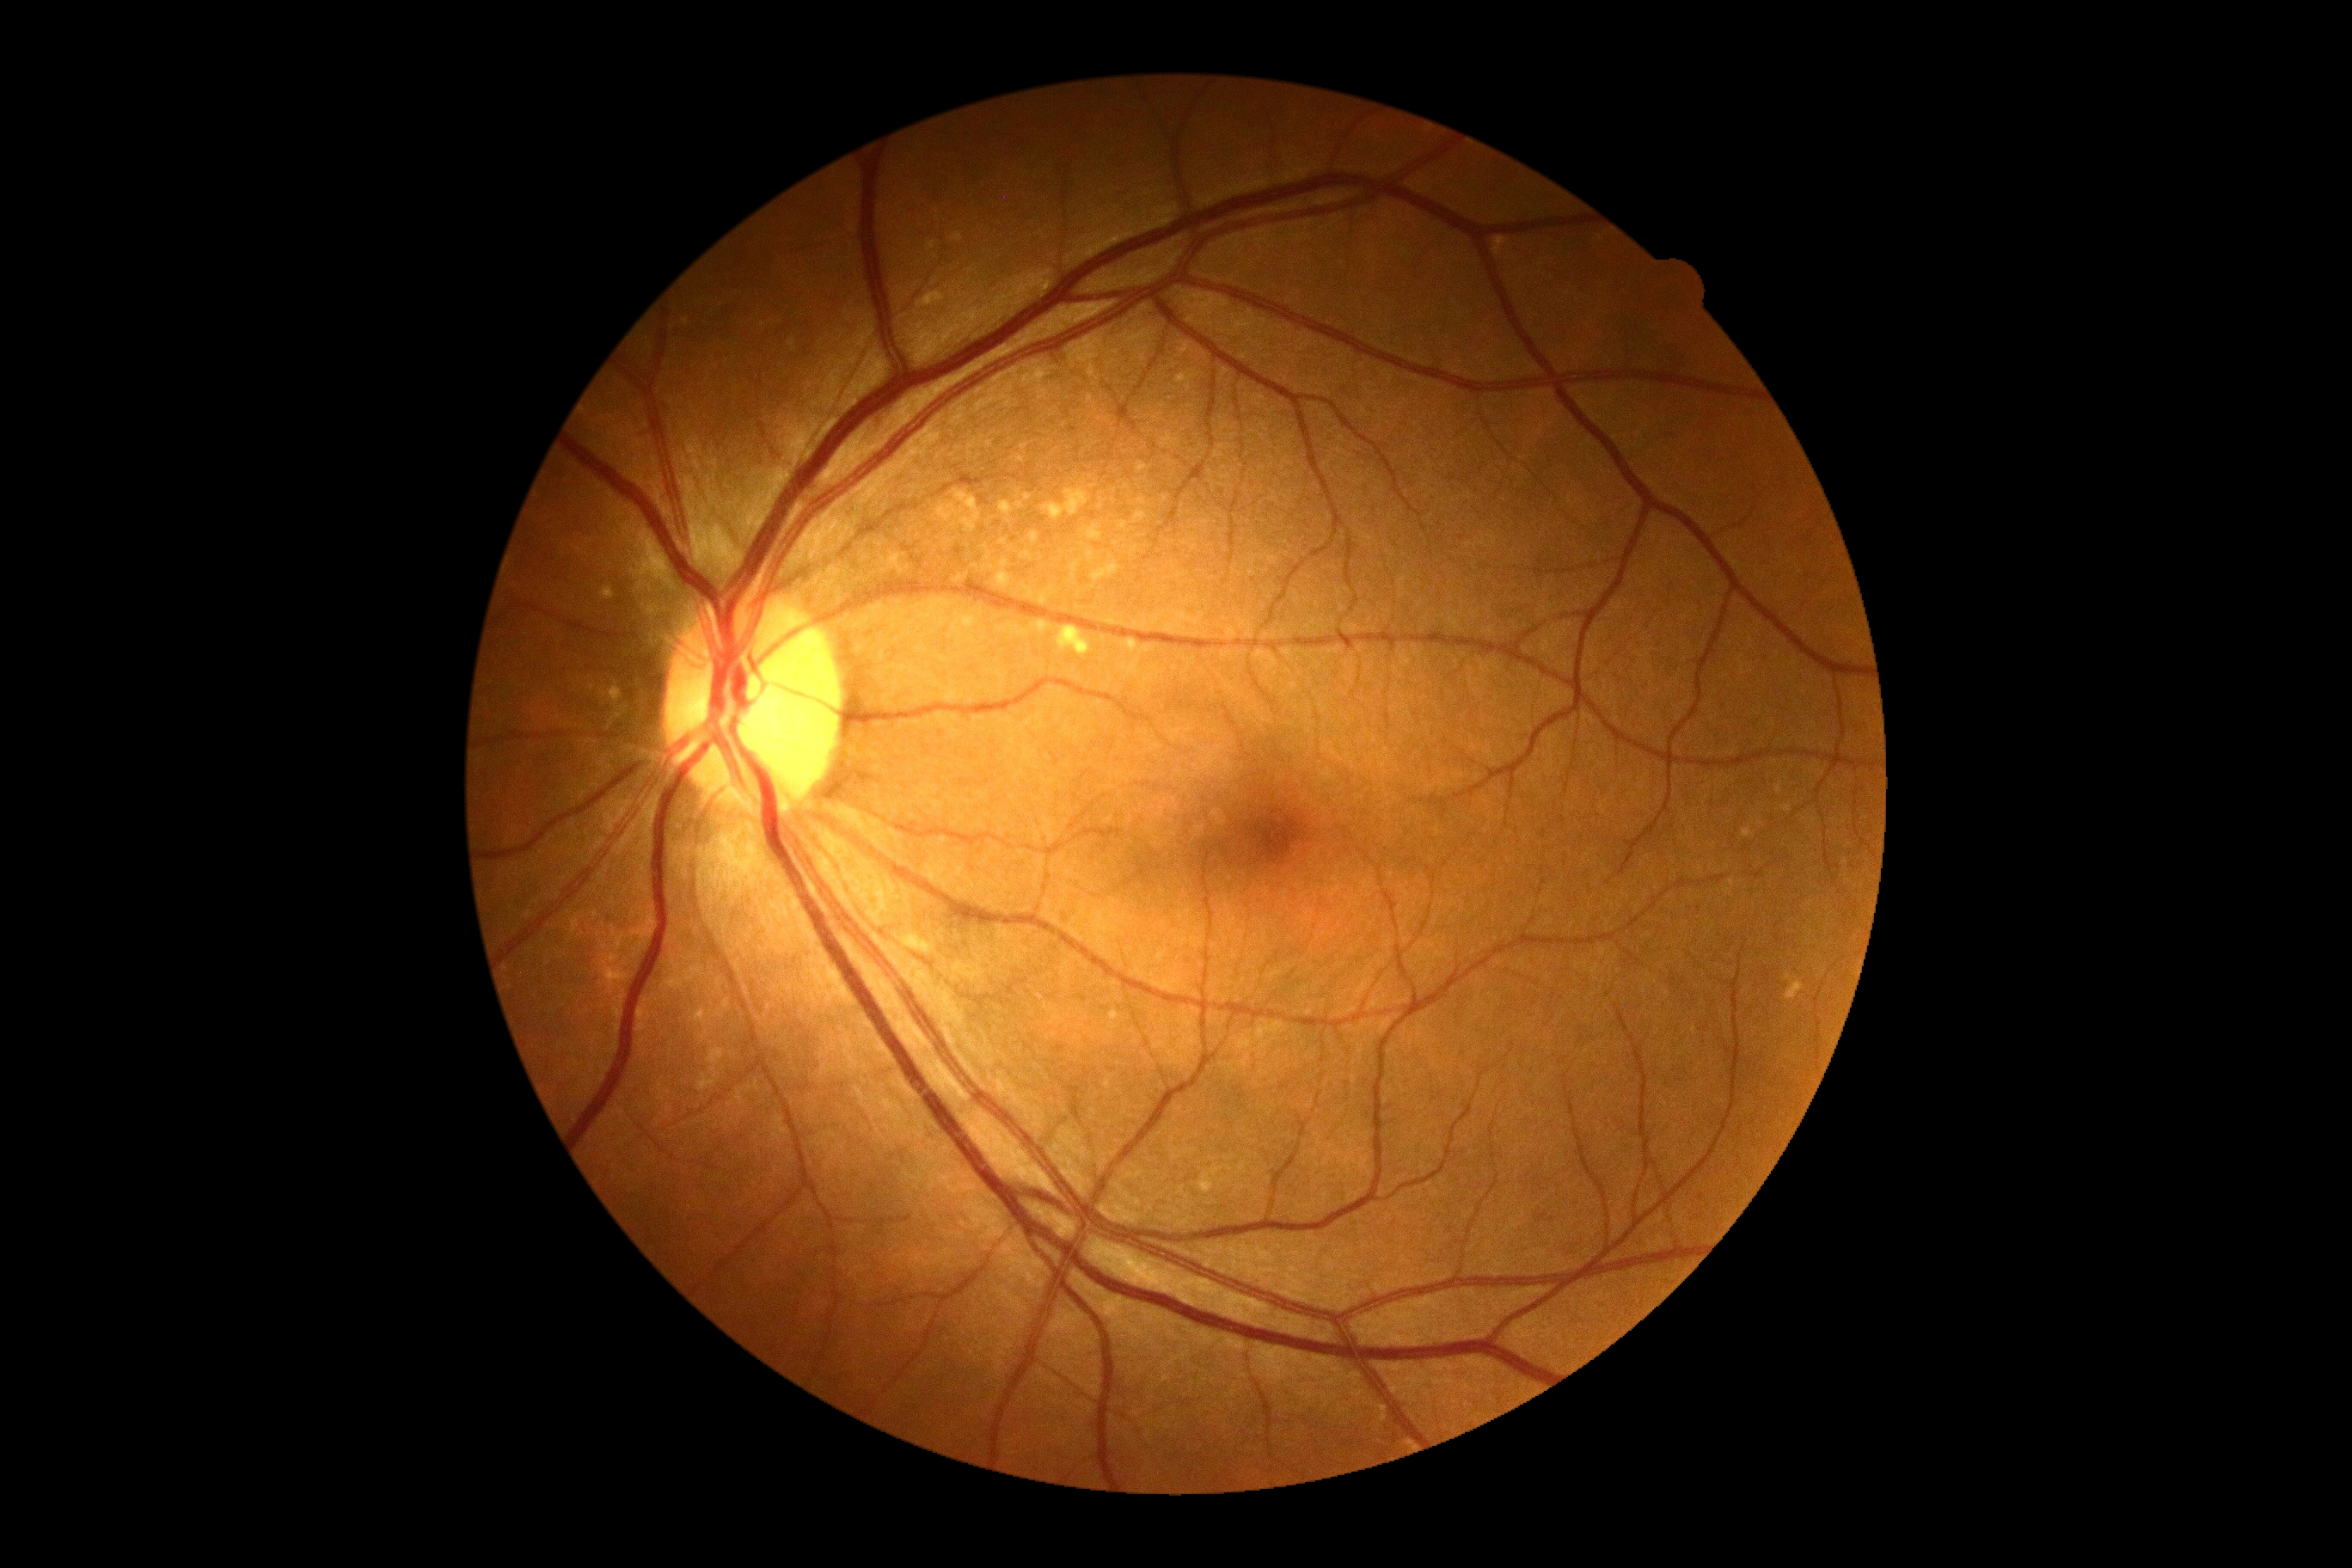
Annotations:
– DR impression: negative for DR
– DR stage: 0